Posterior pole photograph; FOV: 45 degrees; nonmydriatic fundus photograph; 848 by 848 pixels; graded on the modified Davis scale; NIDEK AFC-230 — 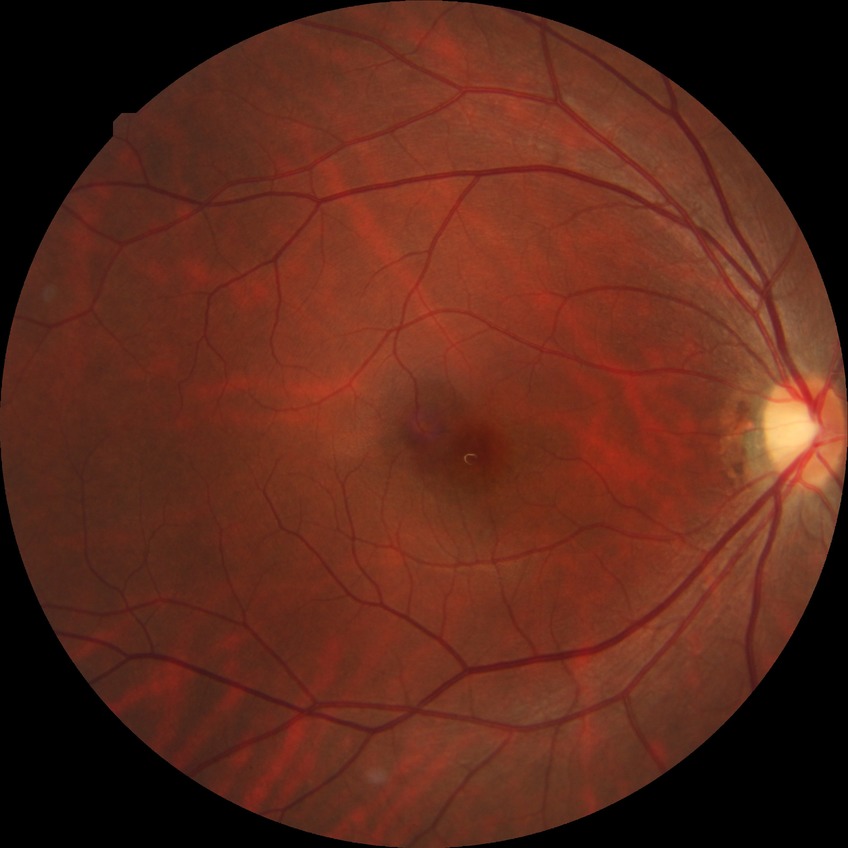 diabetic retinopathy (DR) = no diabetic retinopathy (NDR).